45° FOV. 2048 by 1536 pixels:
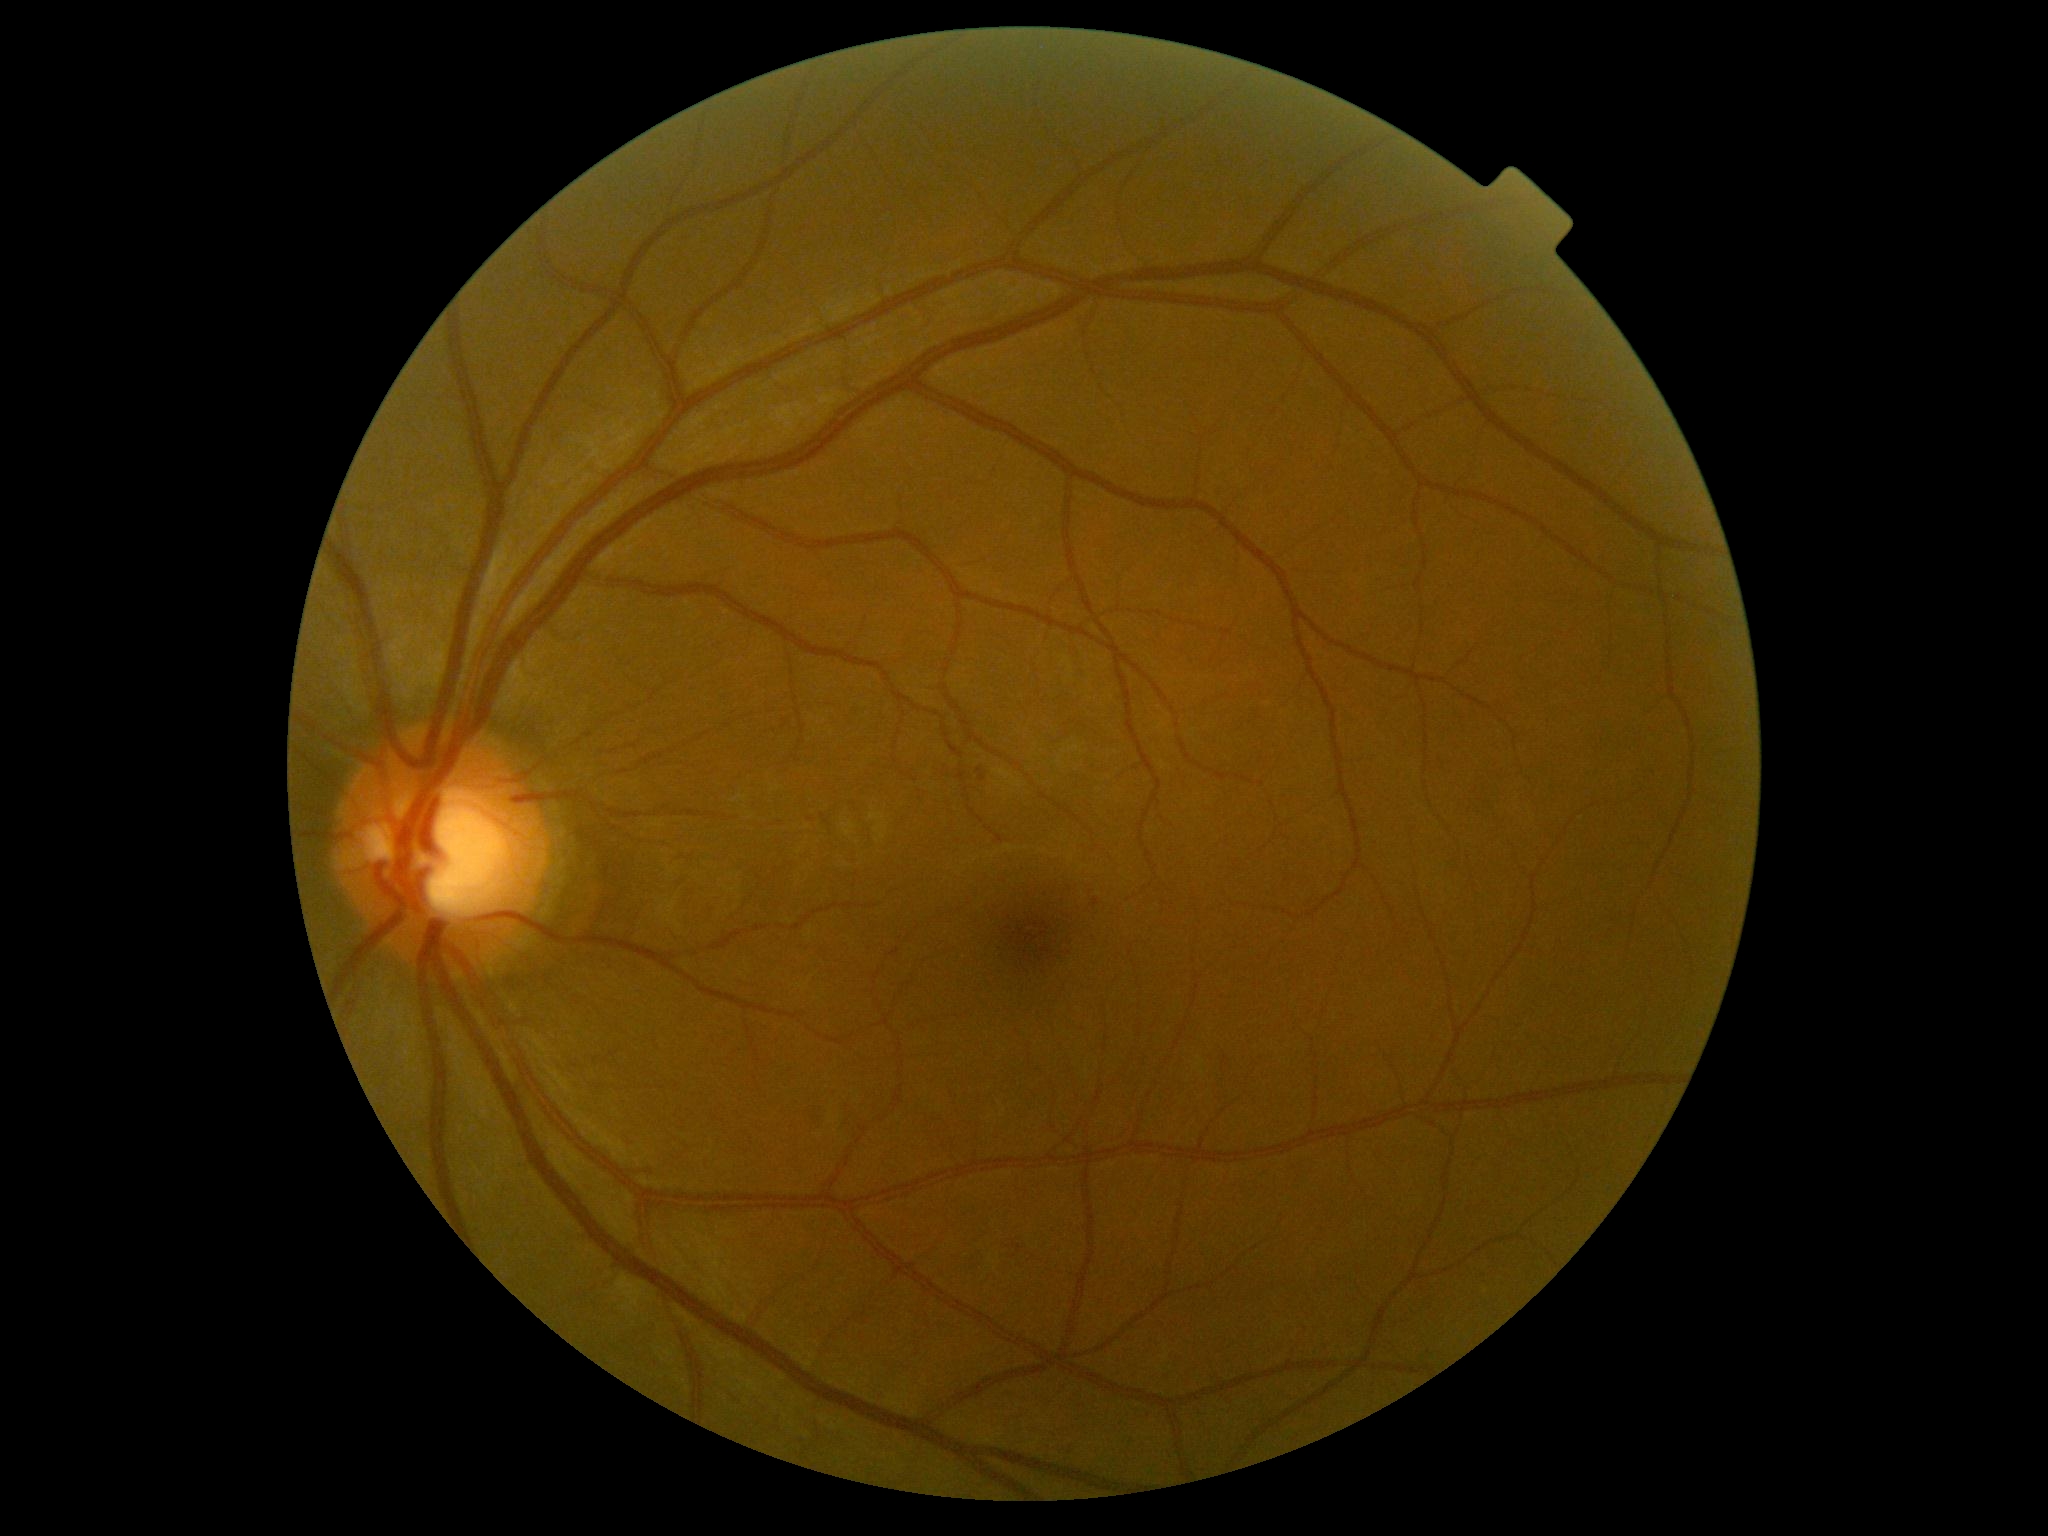

DR class@non-proliferative diabetic retinopathy; diabetic retinopathy (DR)@2/4.